45° FOV; CFP; image size 1380x1382: 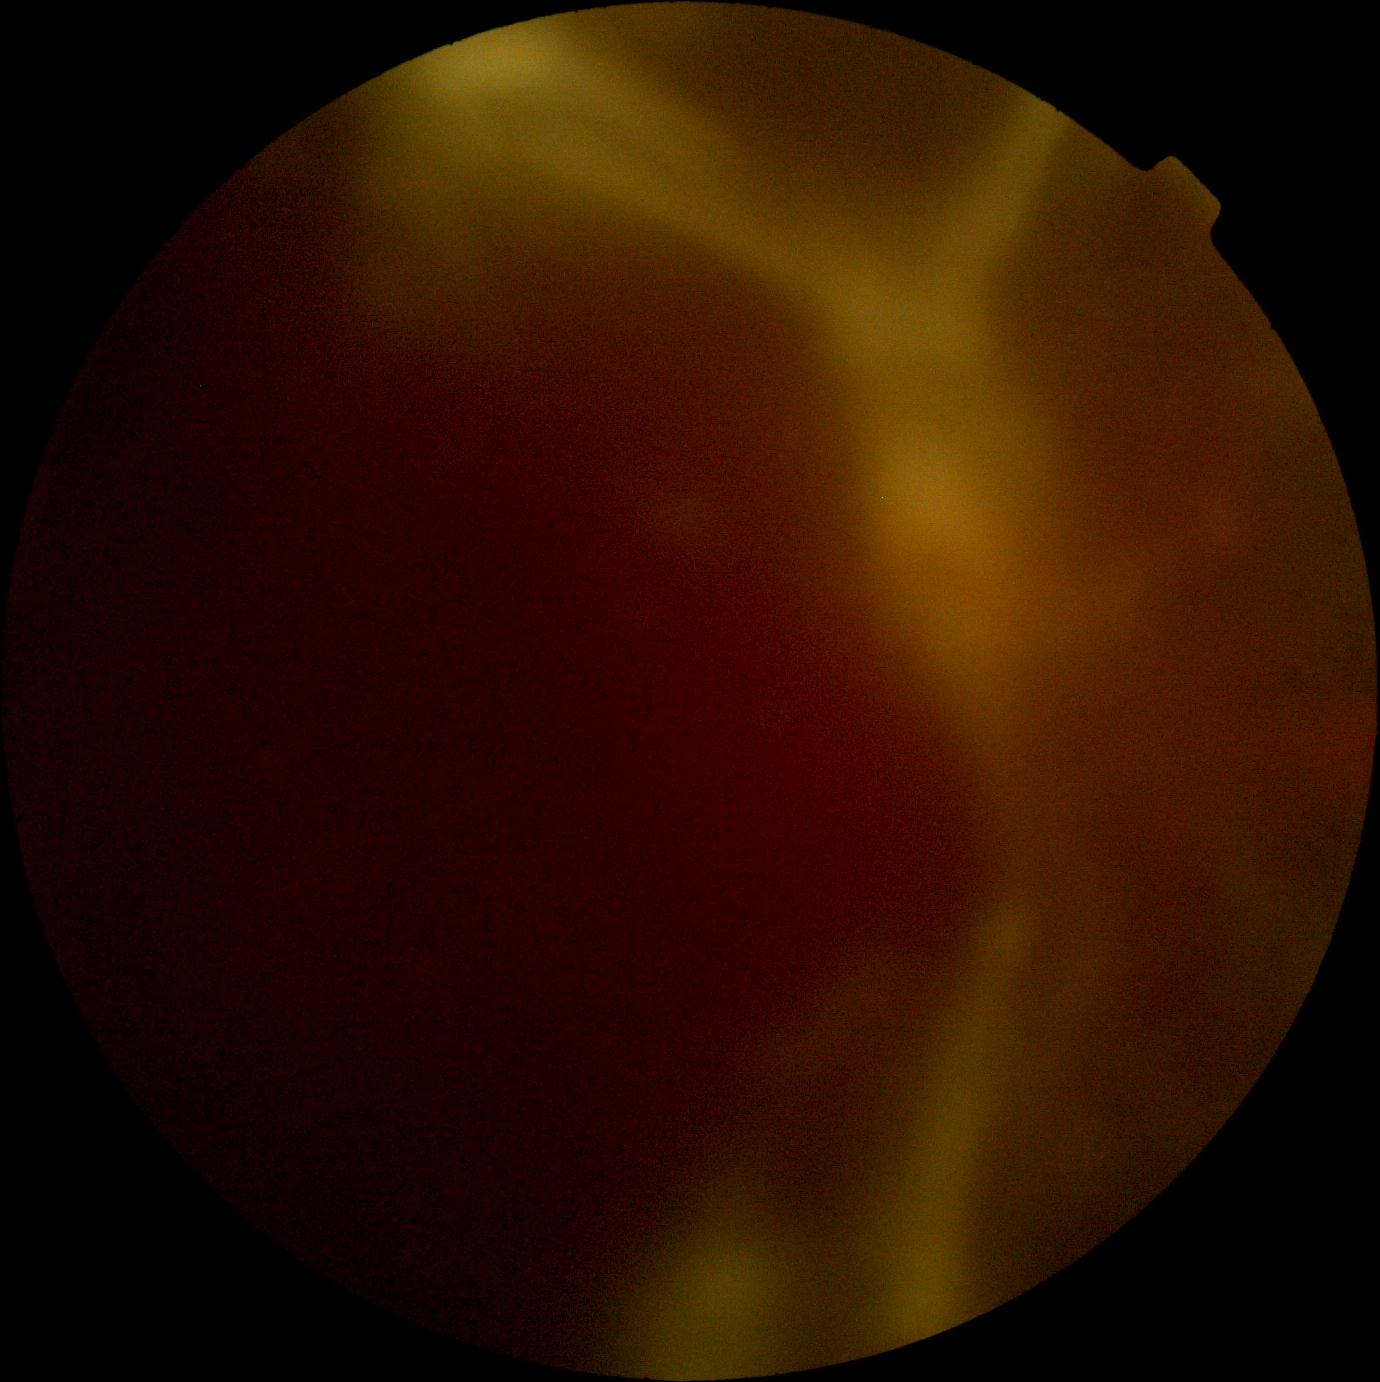 DR: grade 4.